2352x1568px · 45° FOV · retinal fundus photograph
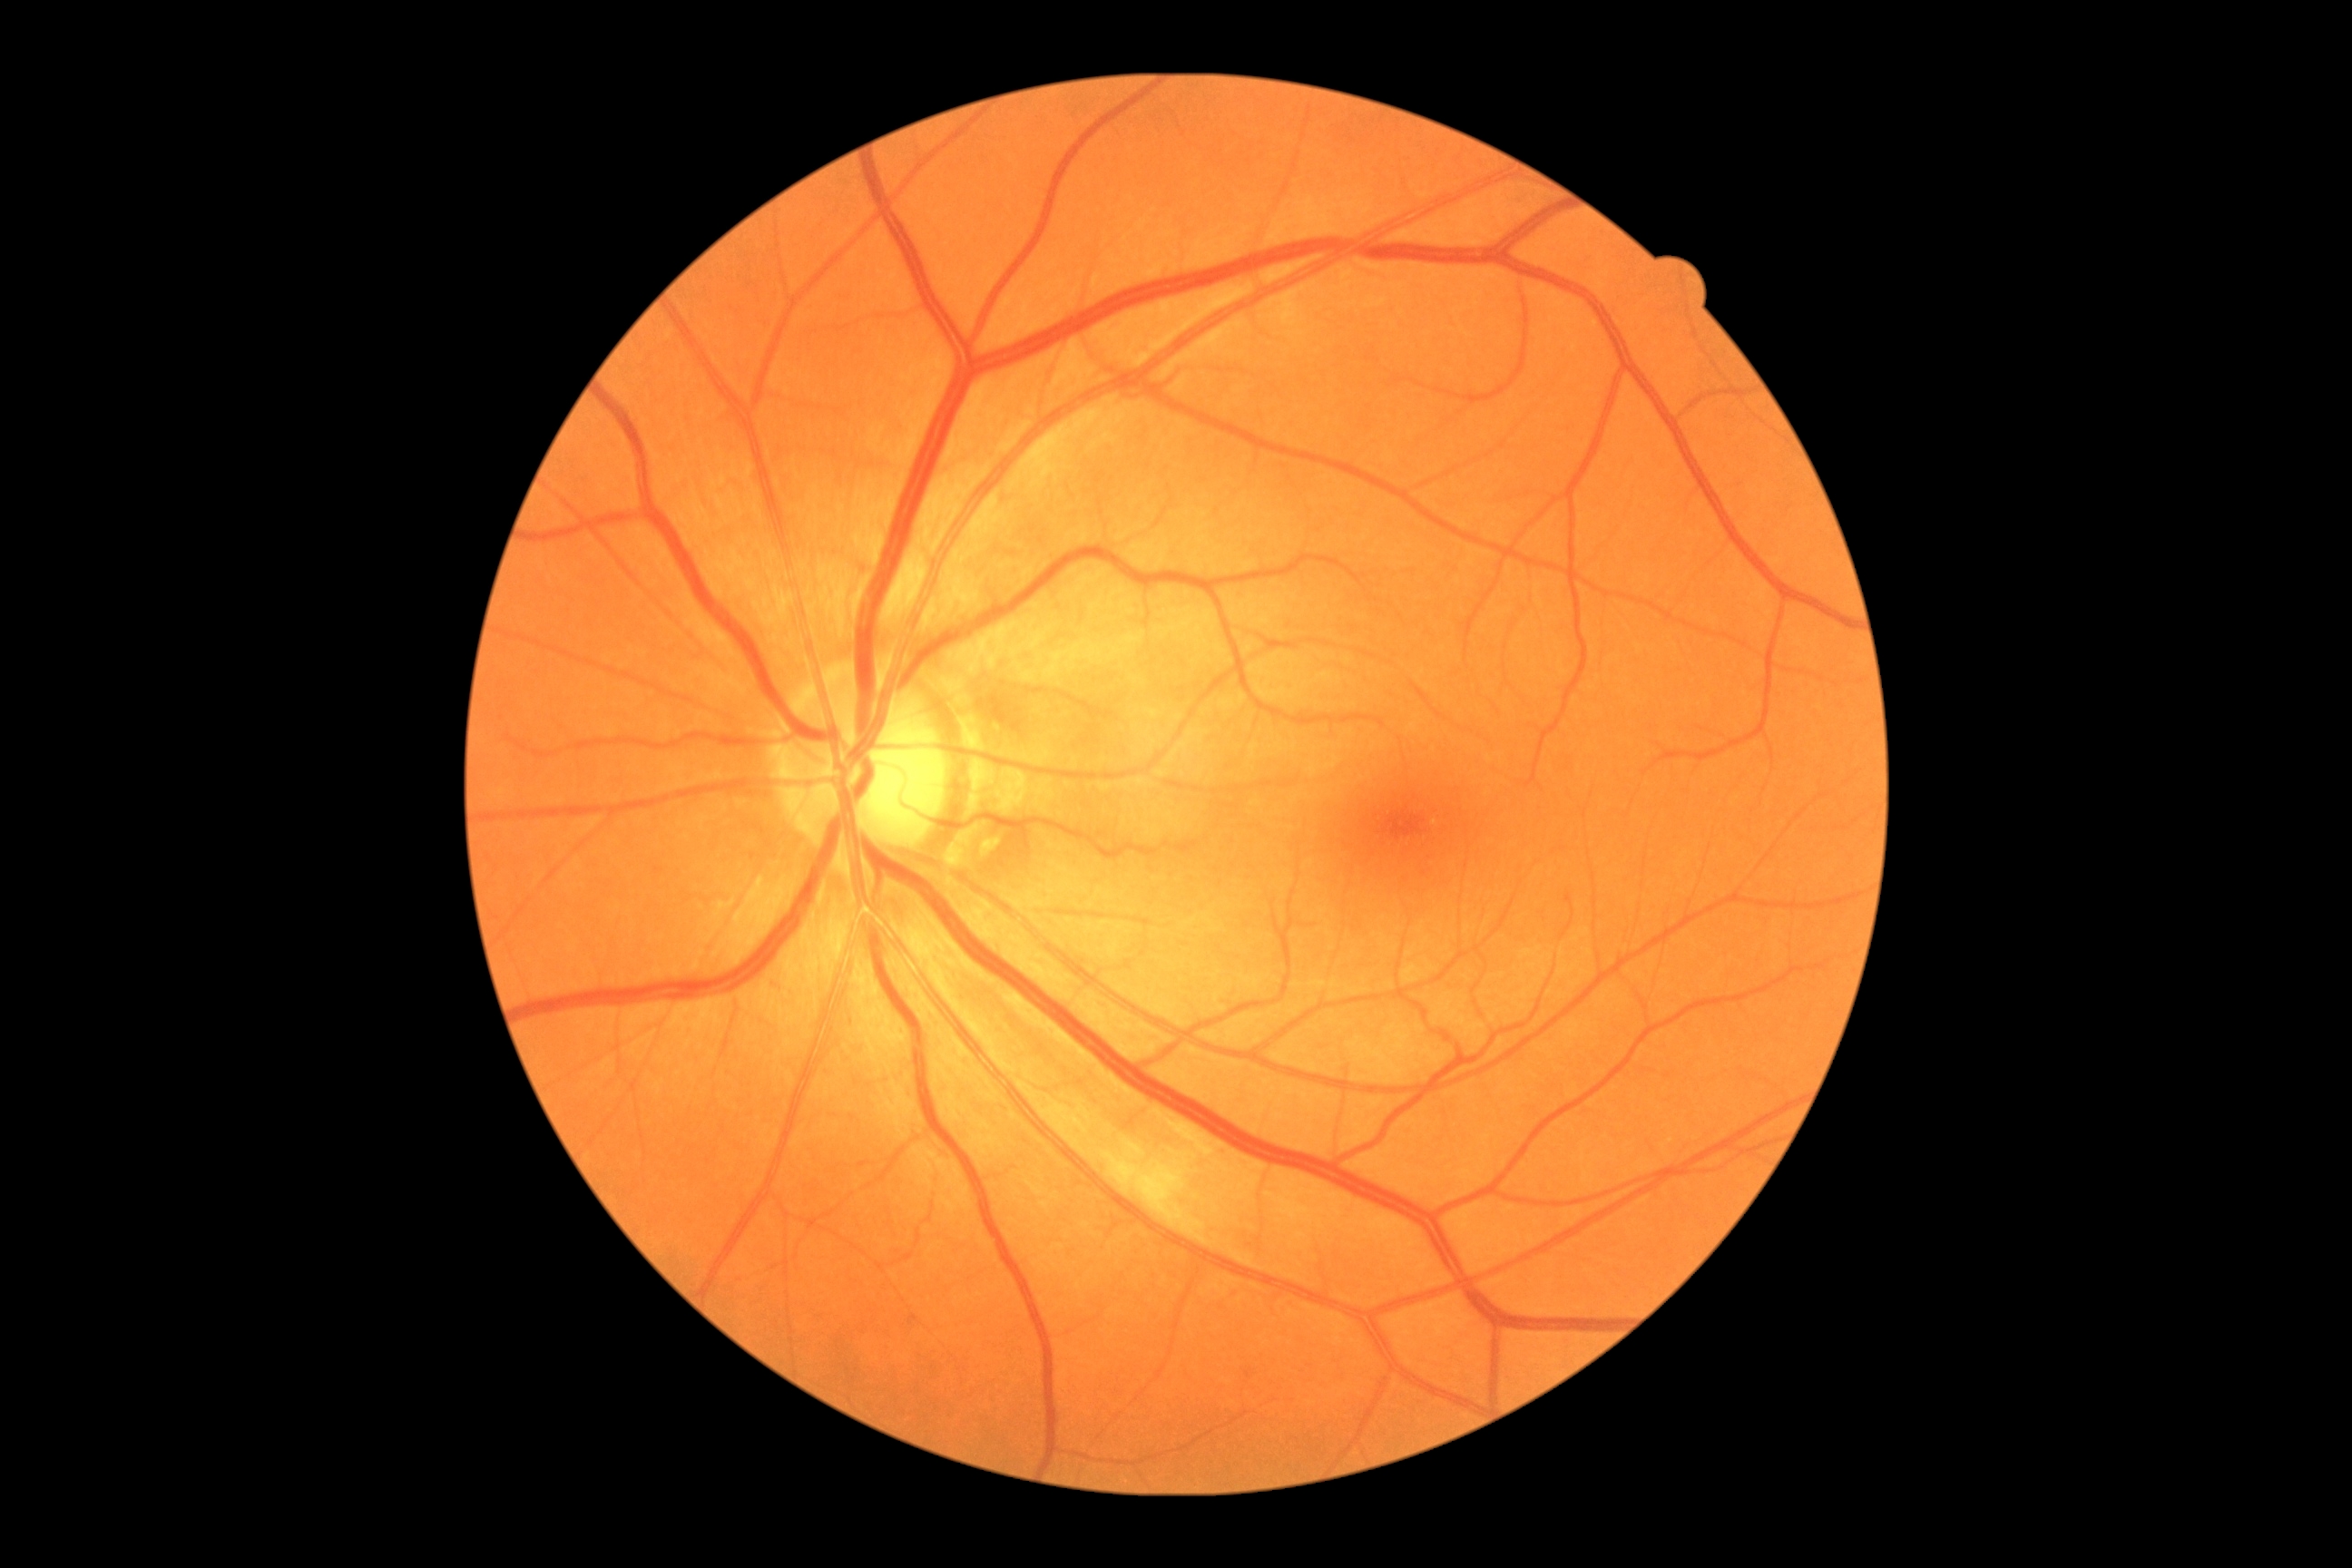 diabetic retinopathy (DR)@grade 2 (moderate NPDR).